2048 x 1536 pixels, fundus photo, camera: Forus 3Nethra Classic:
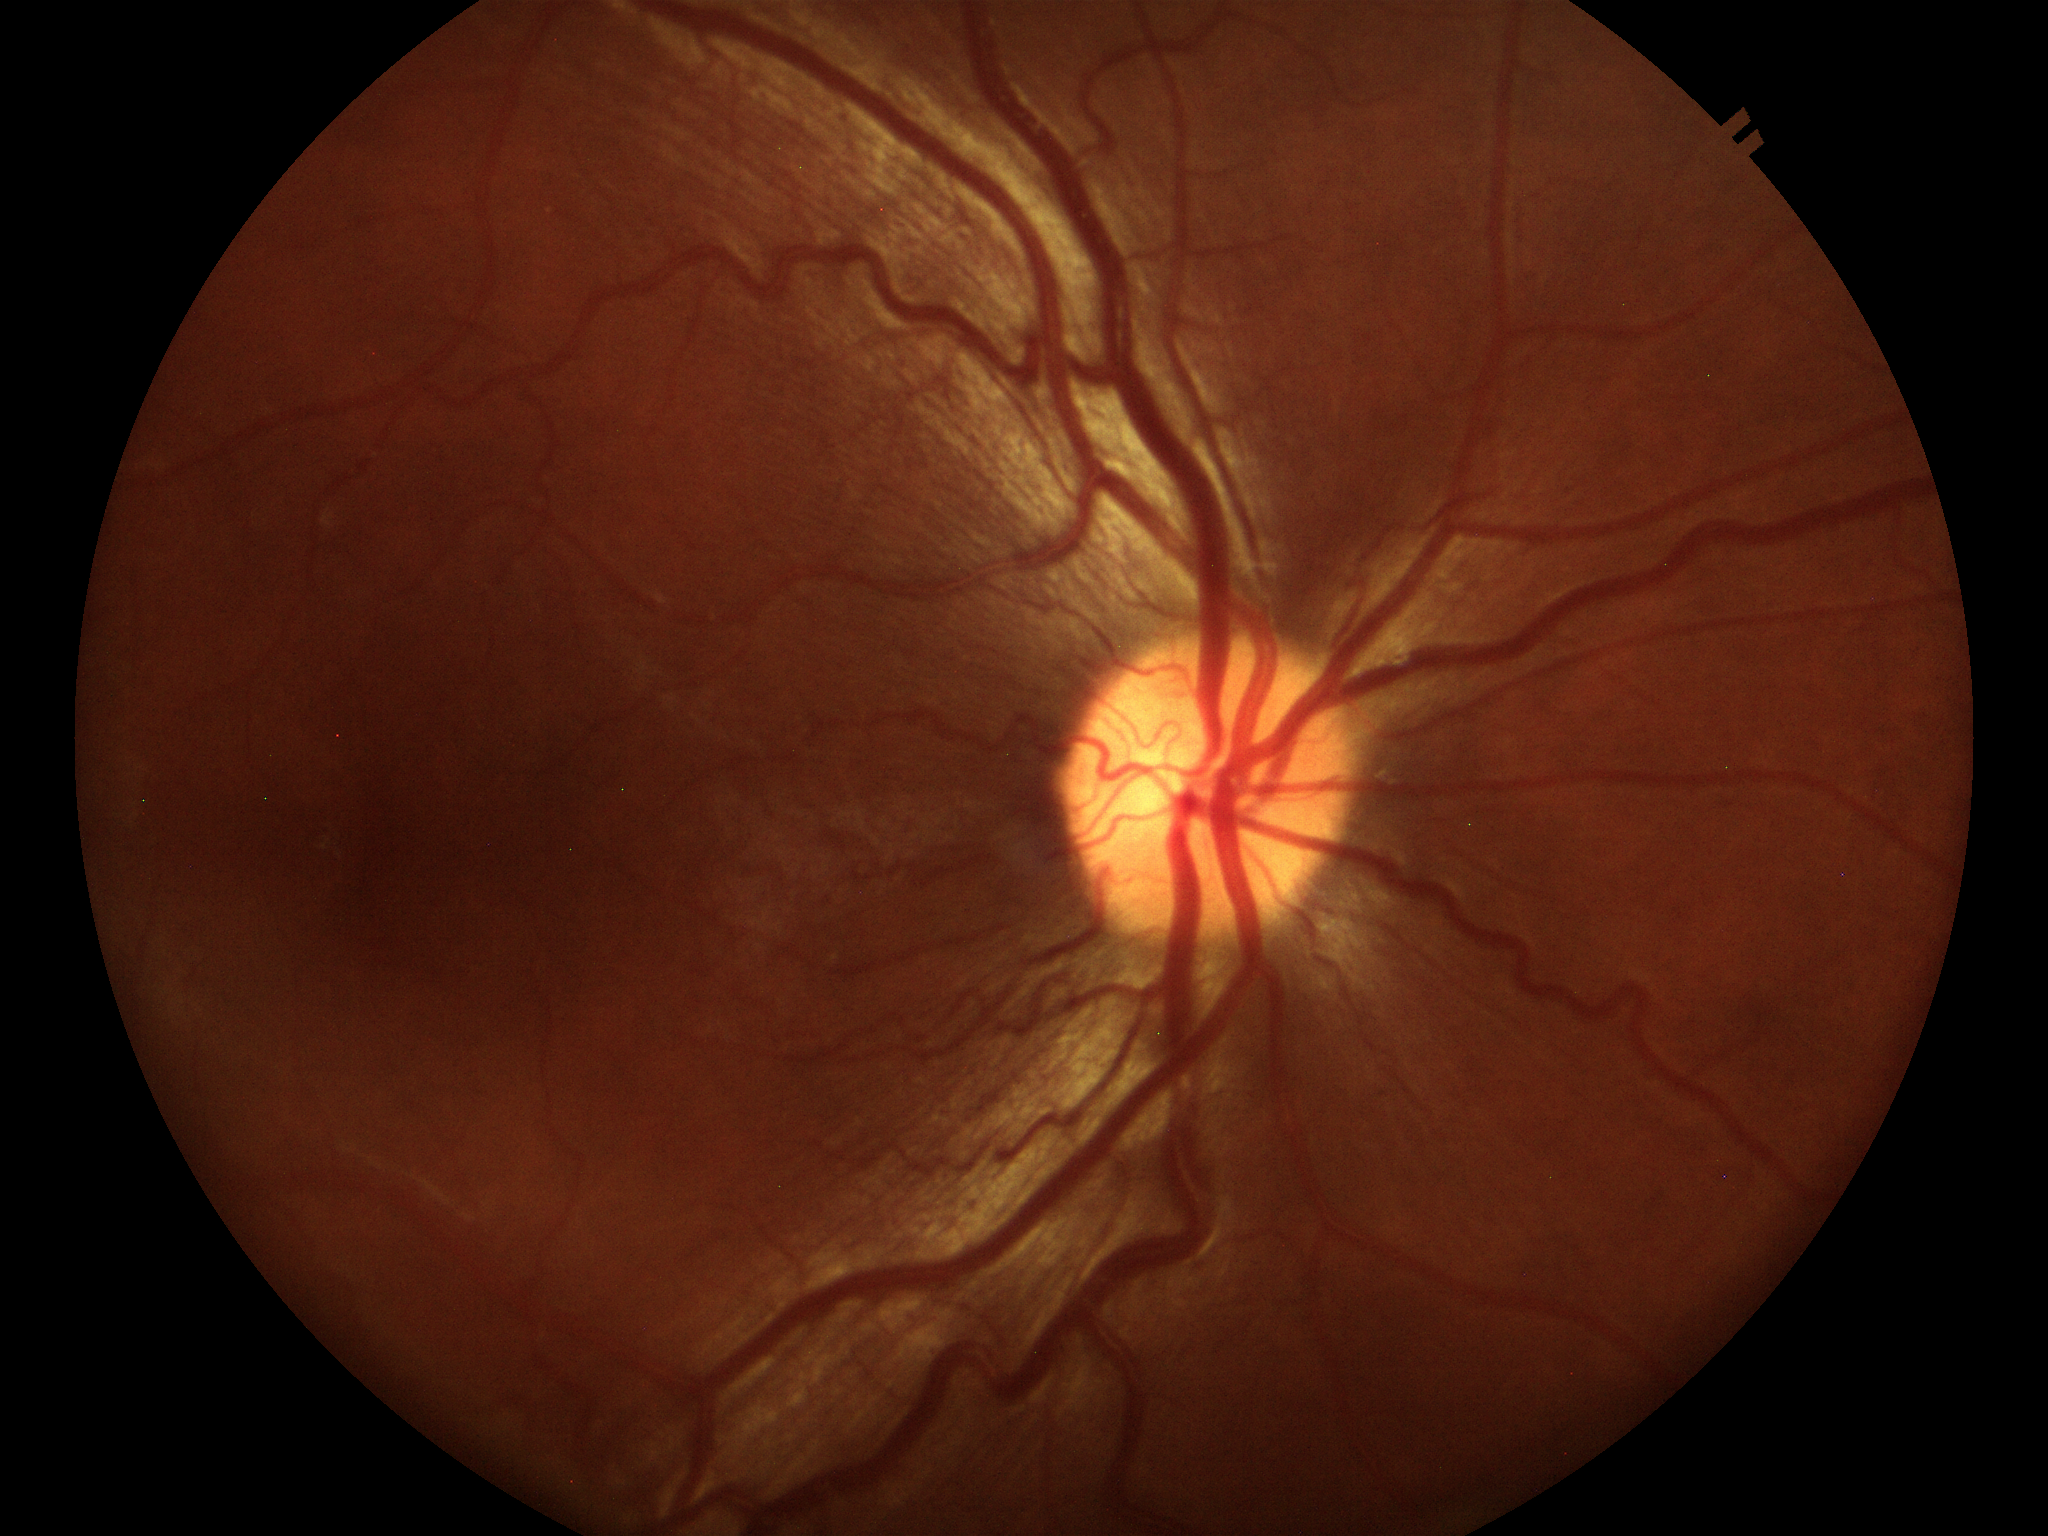
horizontal CDR = 0.47; vertical cup-to-disc ratio = 0.44; Glaucoma screening = not suspect.